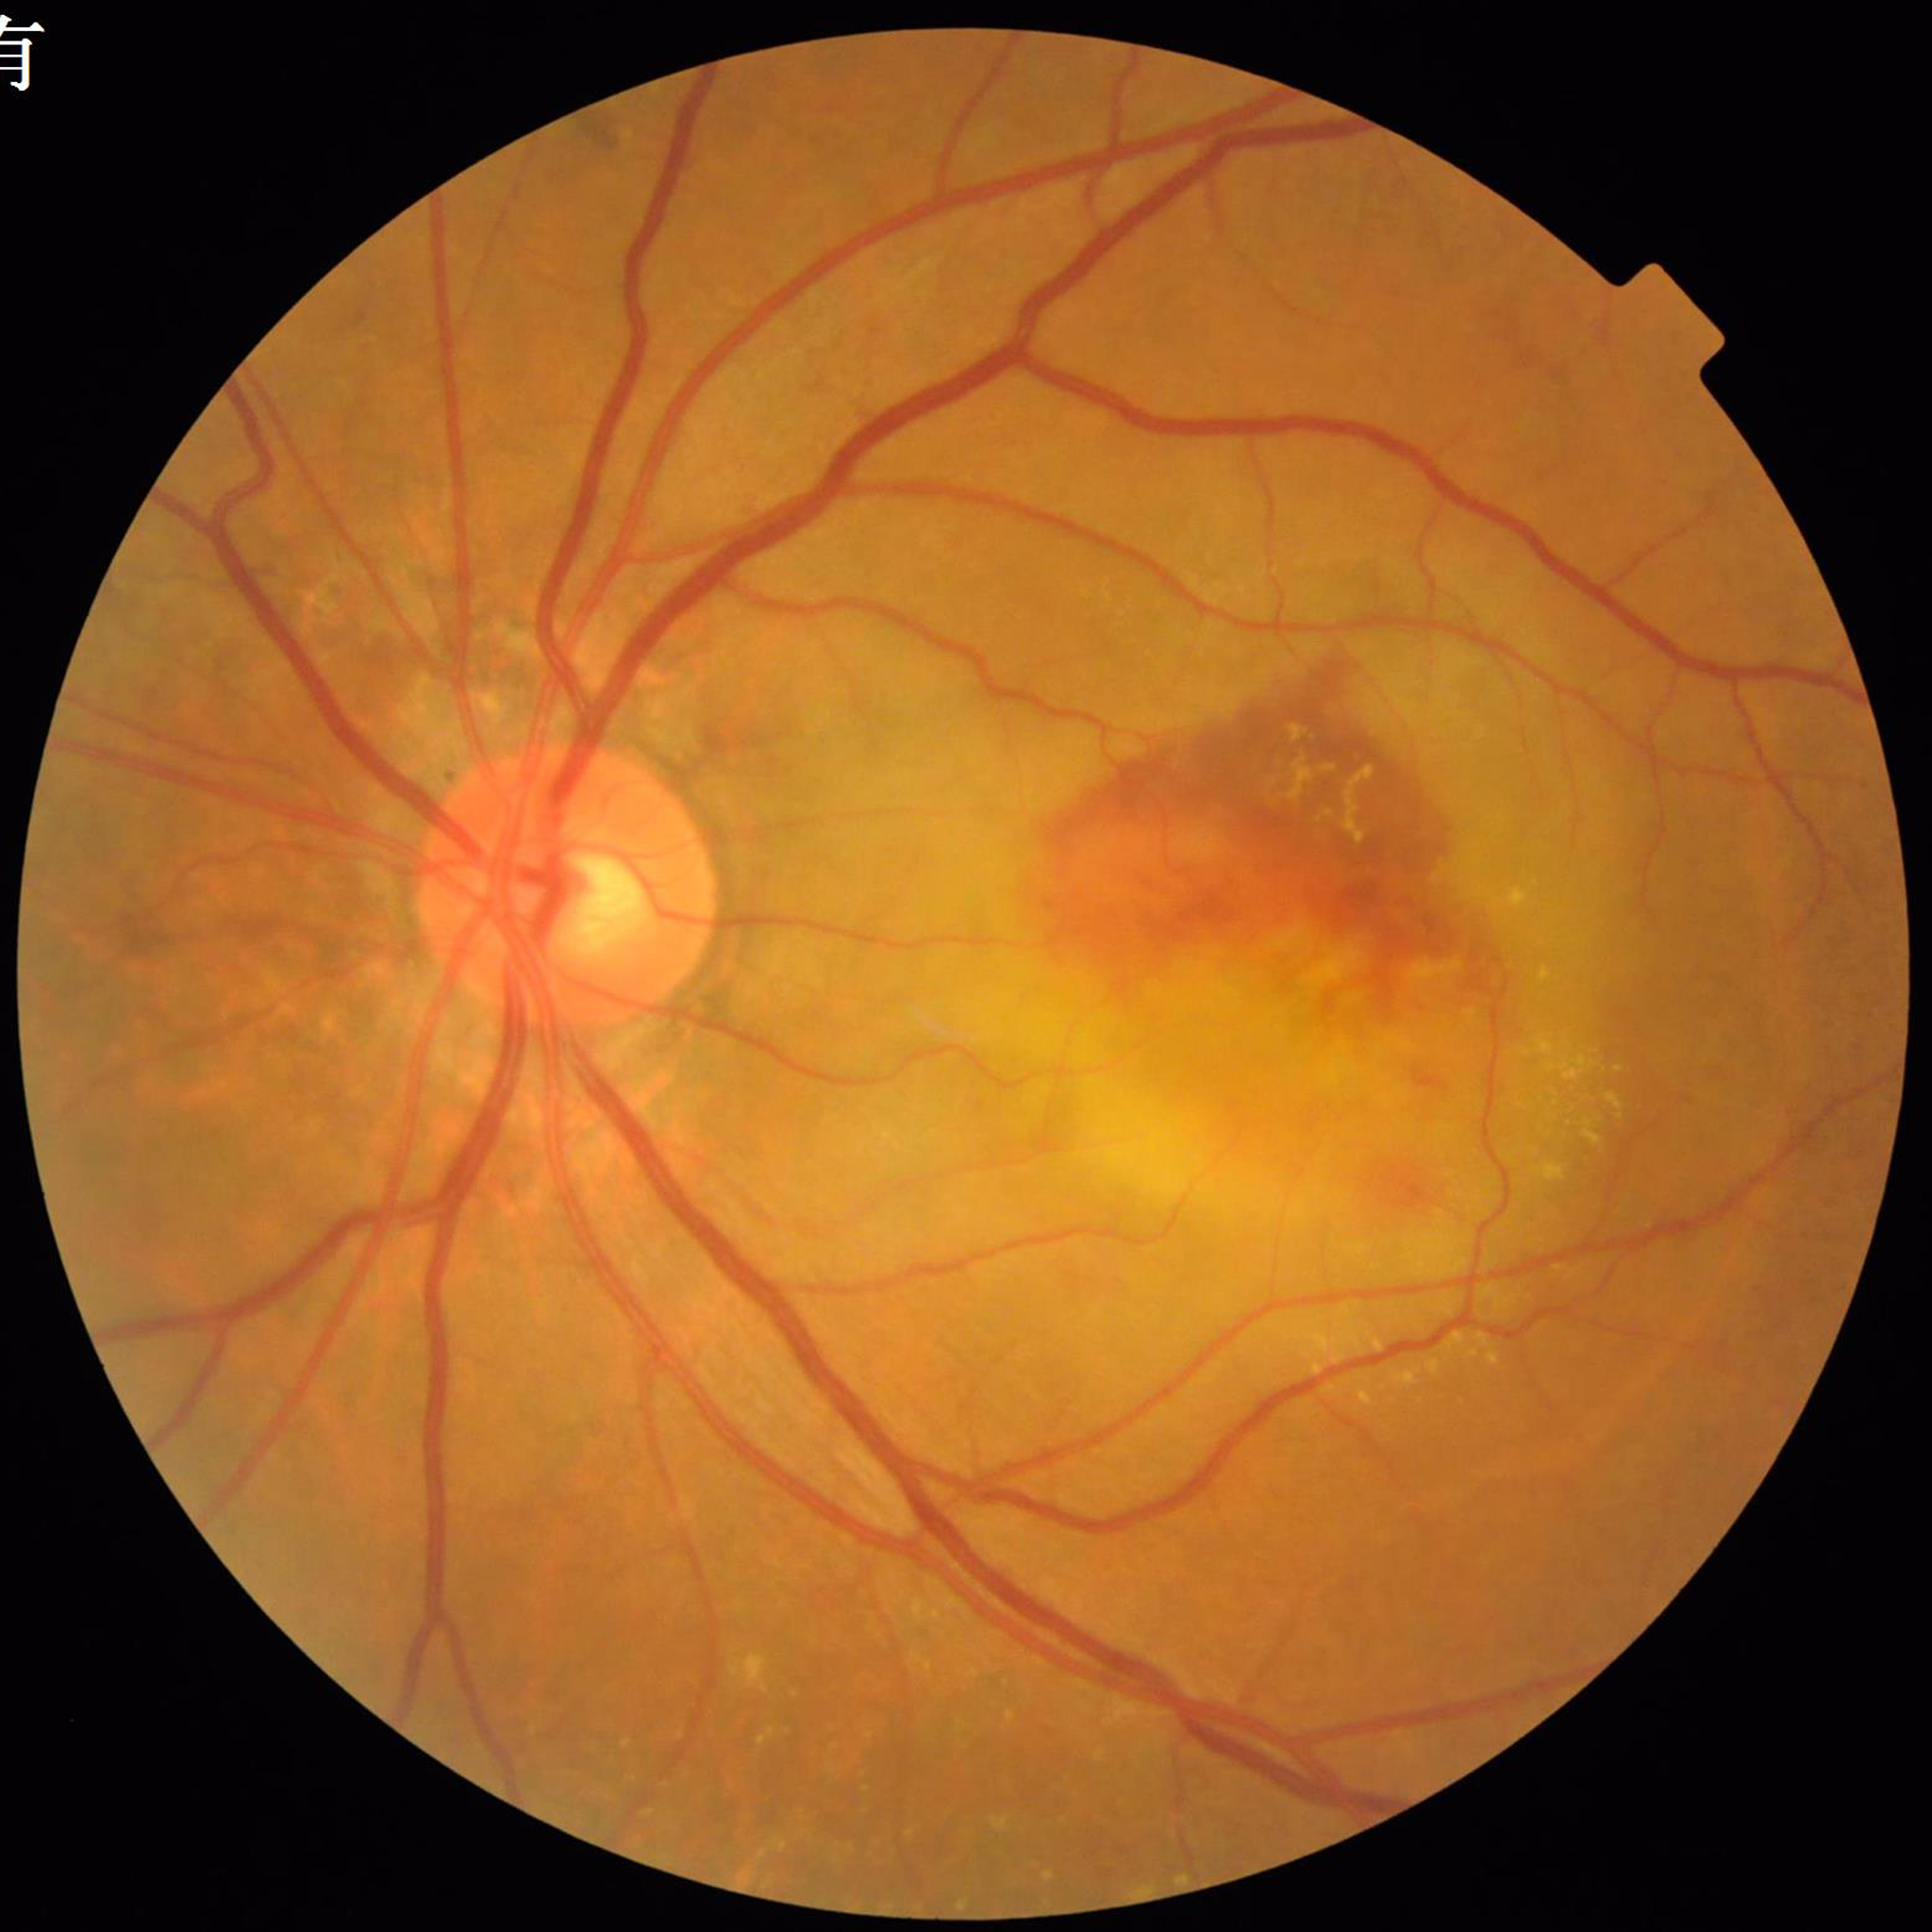
Quality = no quality issues identified; Disease = age-related macular degeneration.